45° field of view, NIDEK AFC-230 fundus camera, 848x848px:
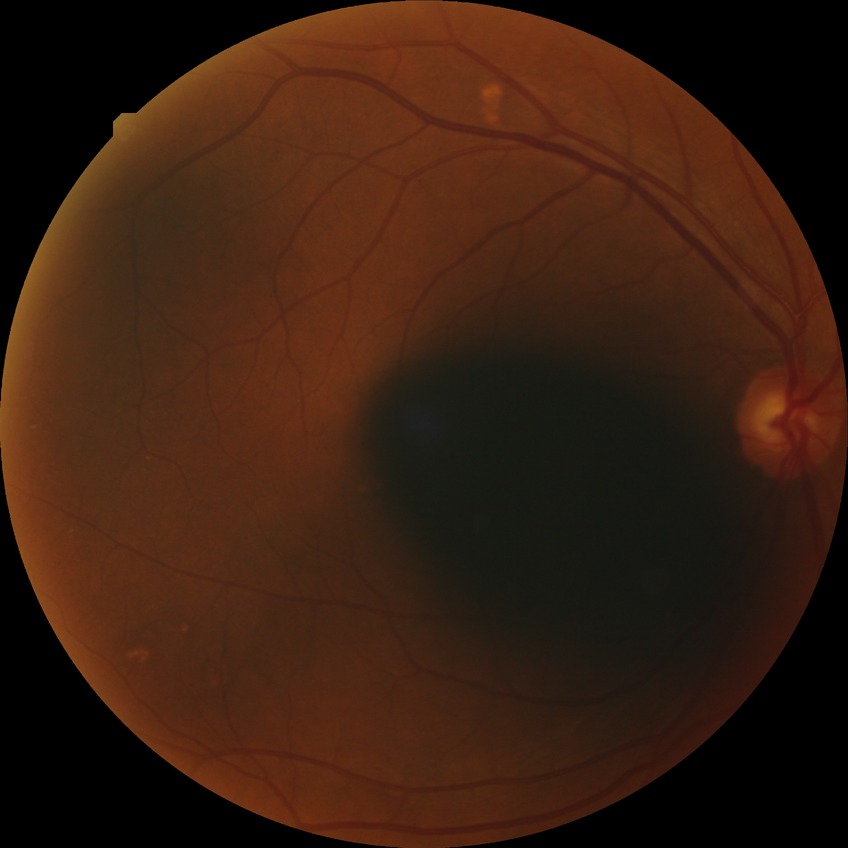

Diabetic retinopathy (DR) is simple diabetic retinopathy (SDR).